1725x1721px:
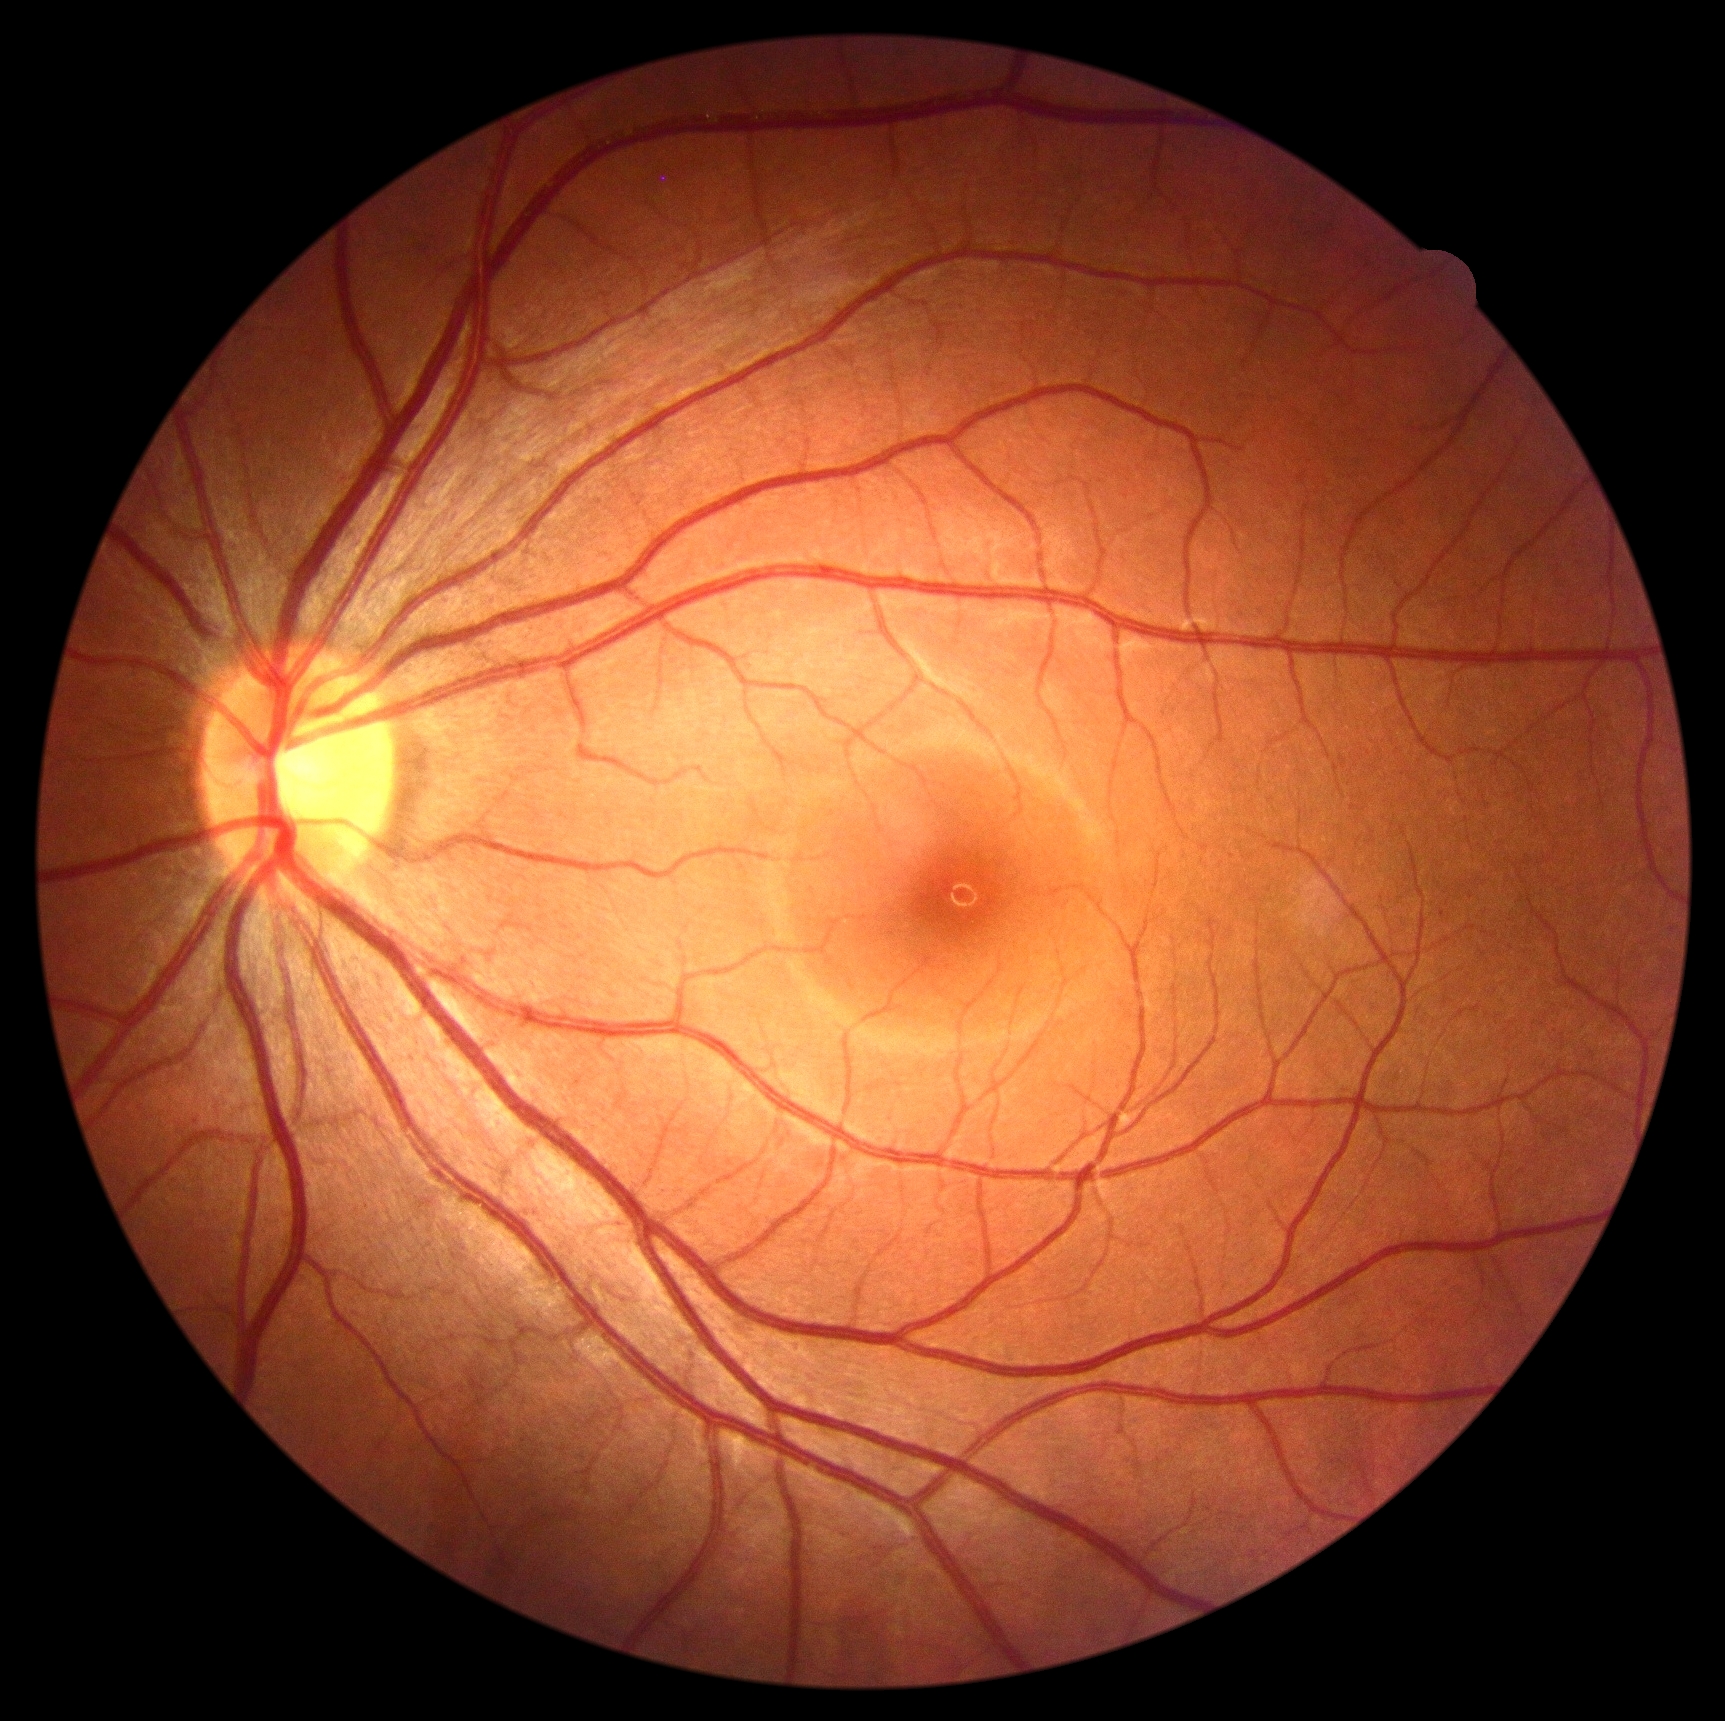
Retinopathy grade: 0 — no visible signs of diabetic retinopathy.